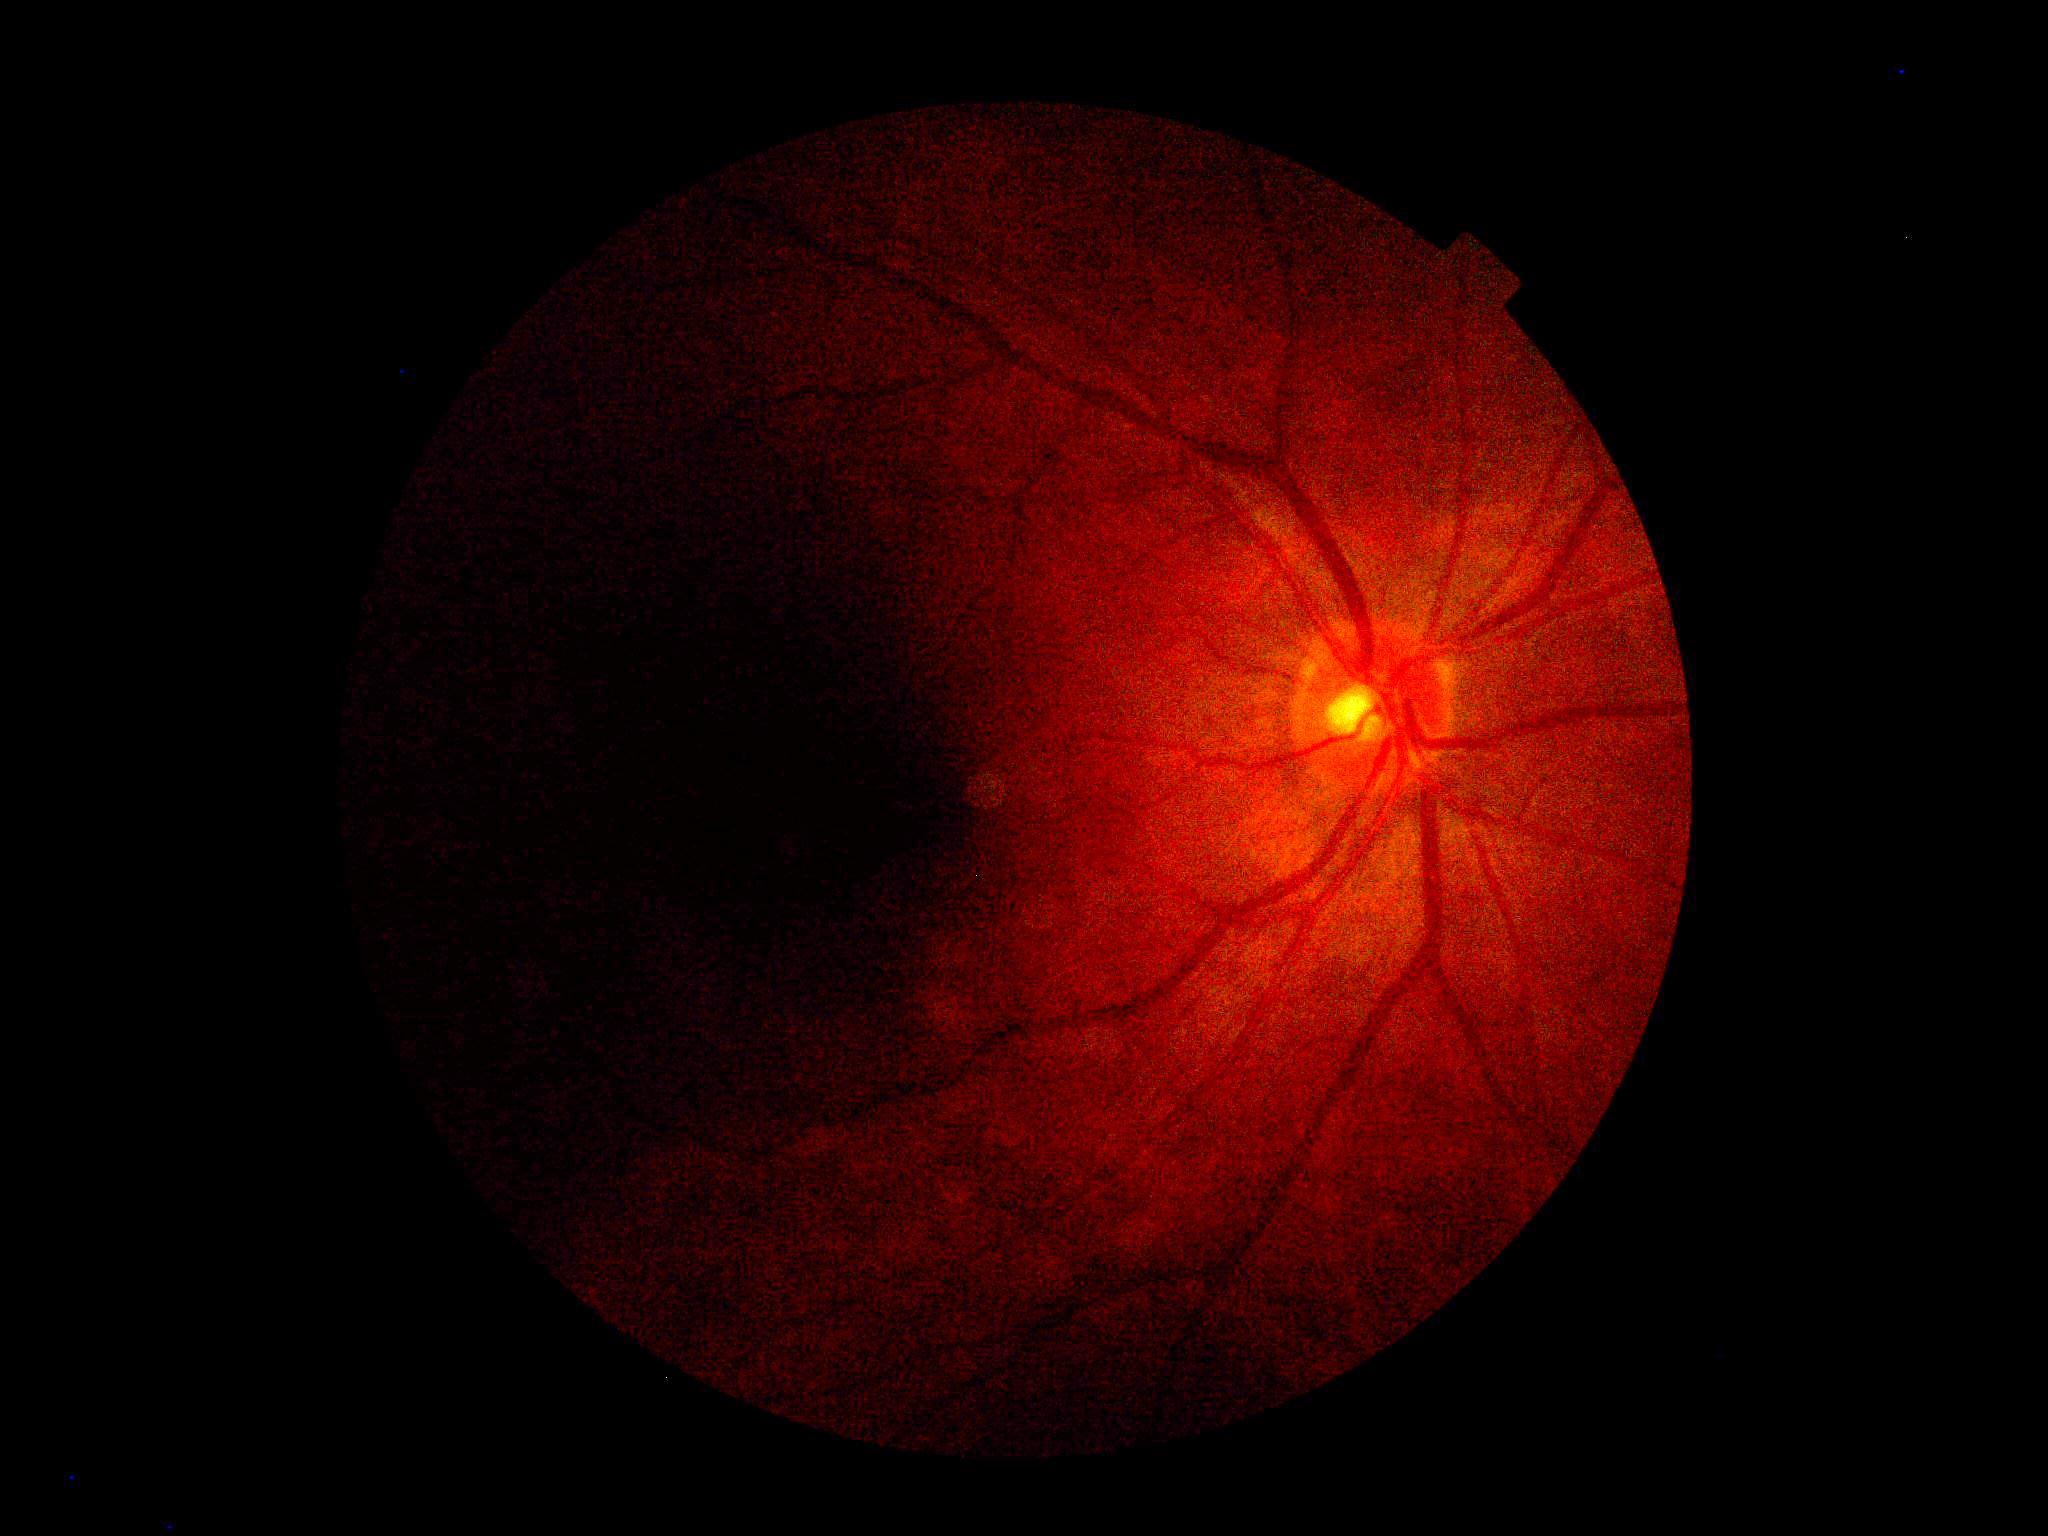 Image quality is insufficient for diabetic retinopathy assessment.
DR severity: ungradable due to poor image quality.